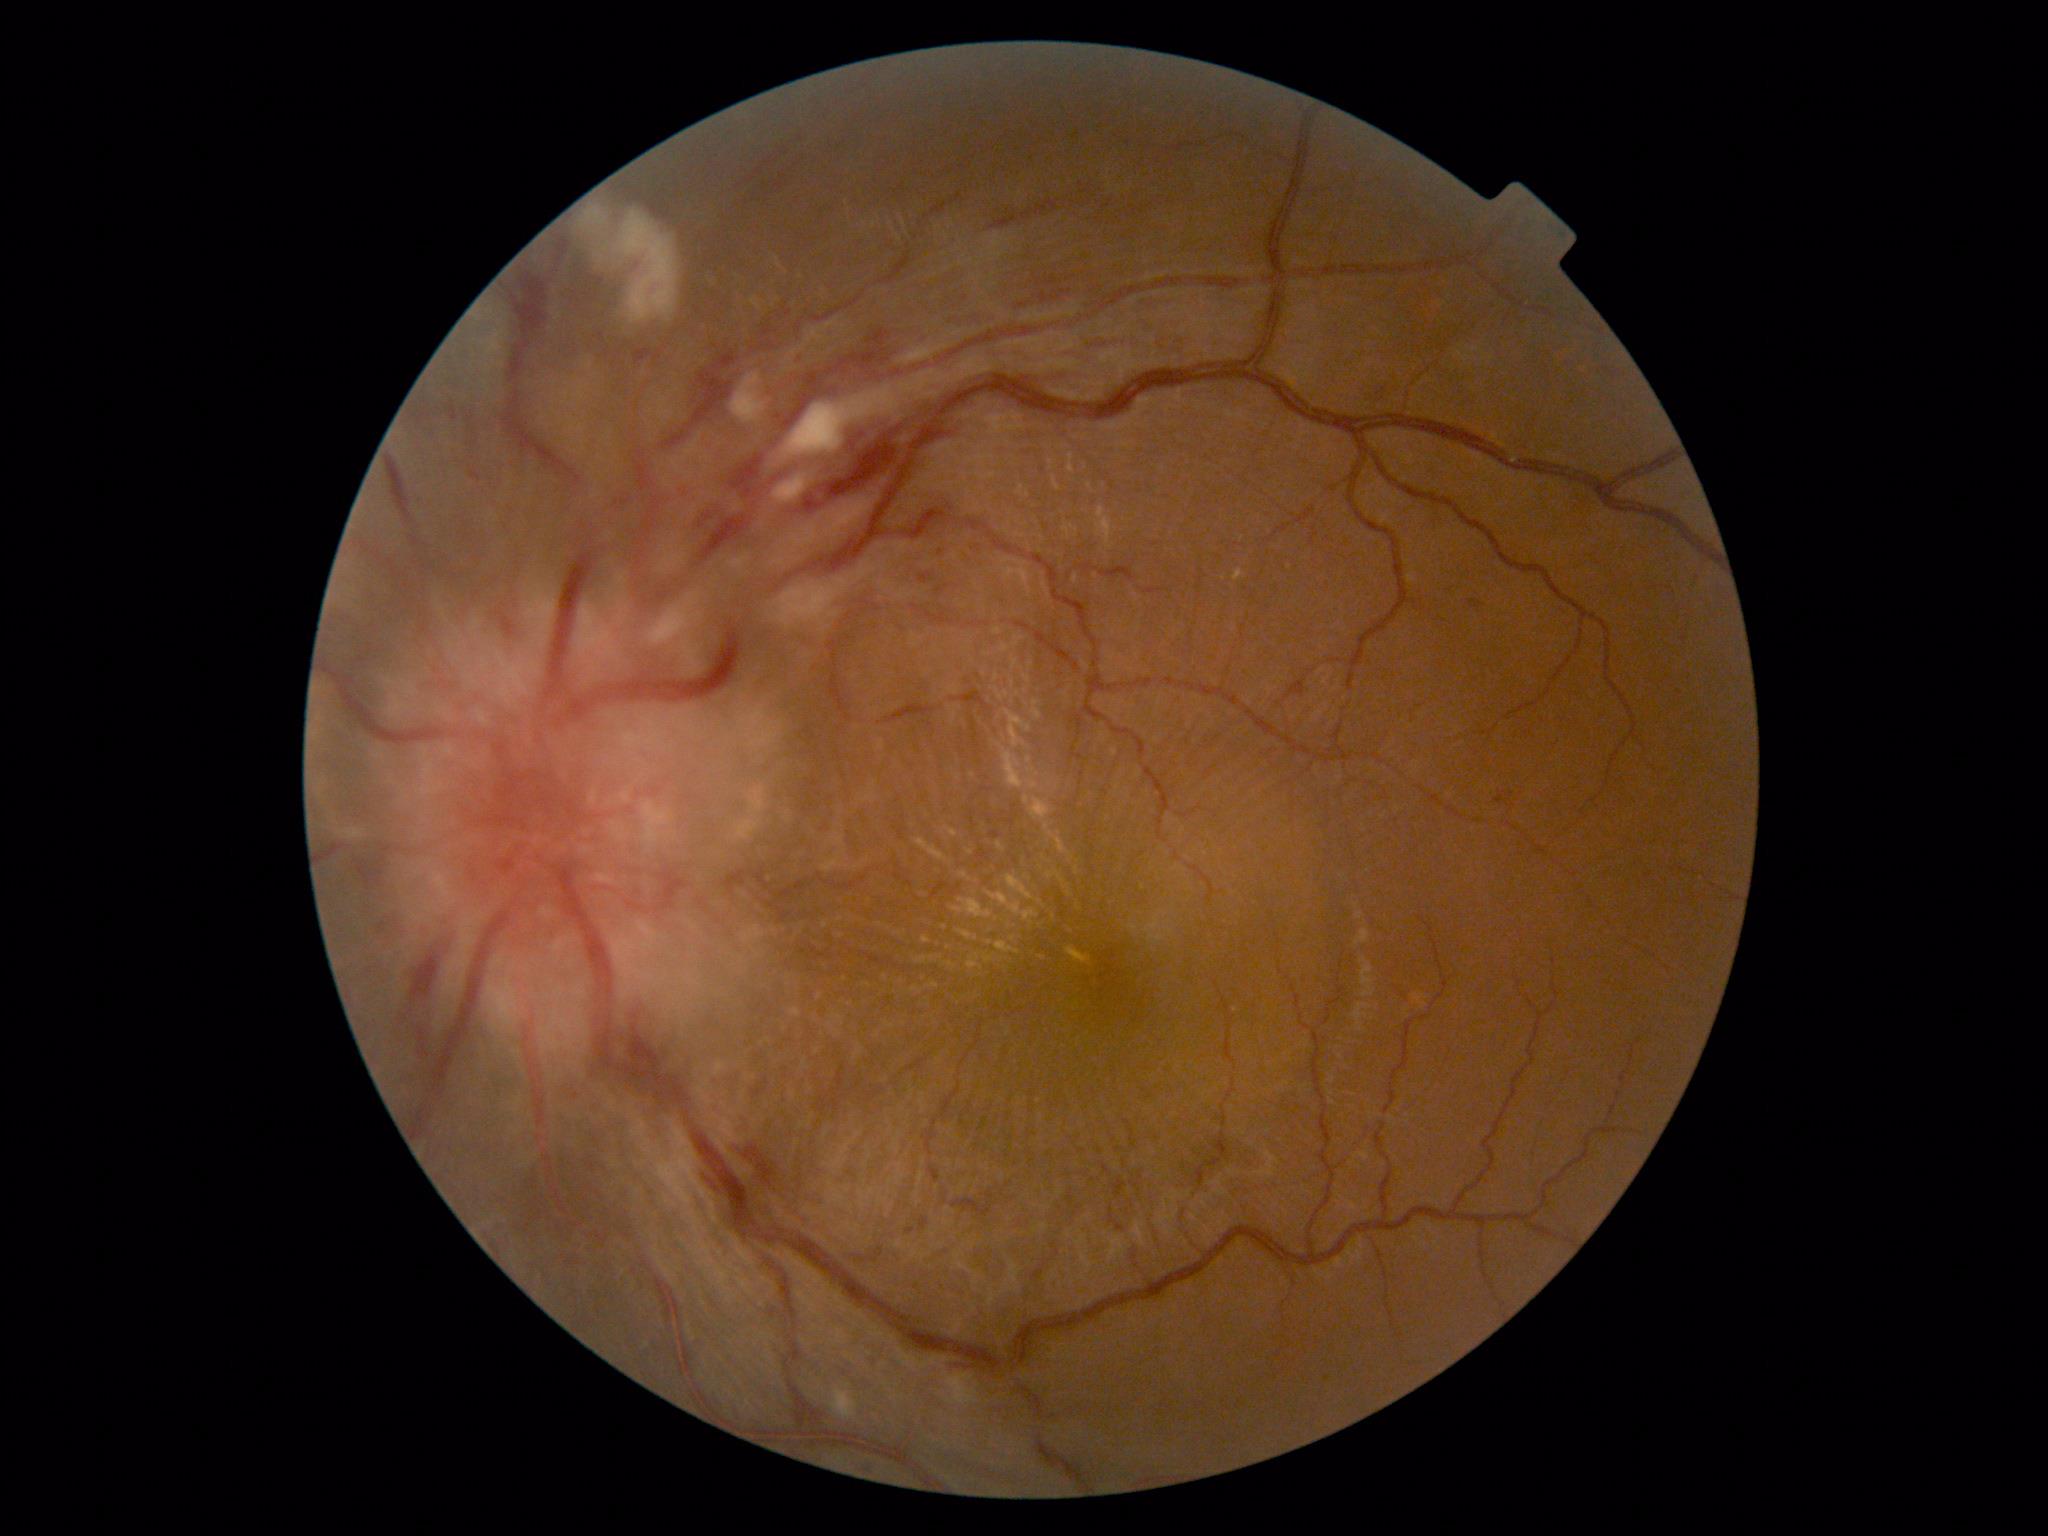

Annotations:
* diabetic retinopathy (DR) — moderate non-proliferative diabetic retinopathy (grade 2) — more than just microaneurysms but less than severe NPDR
* DR class — non-proliferative diabetic retinopathy